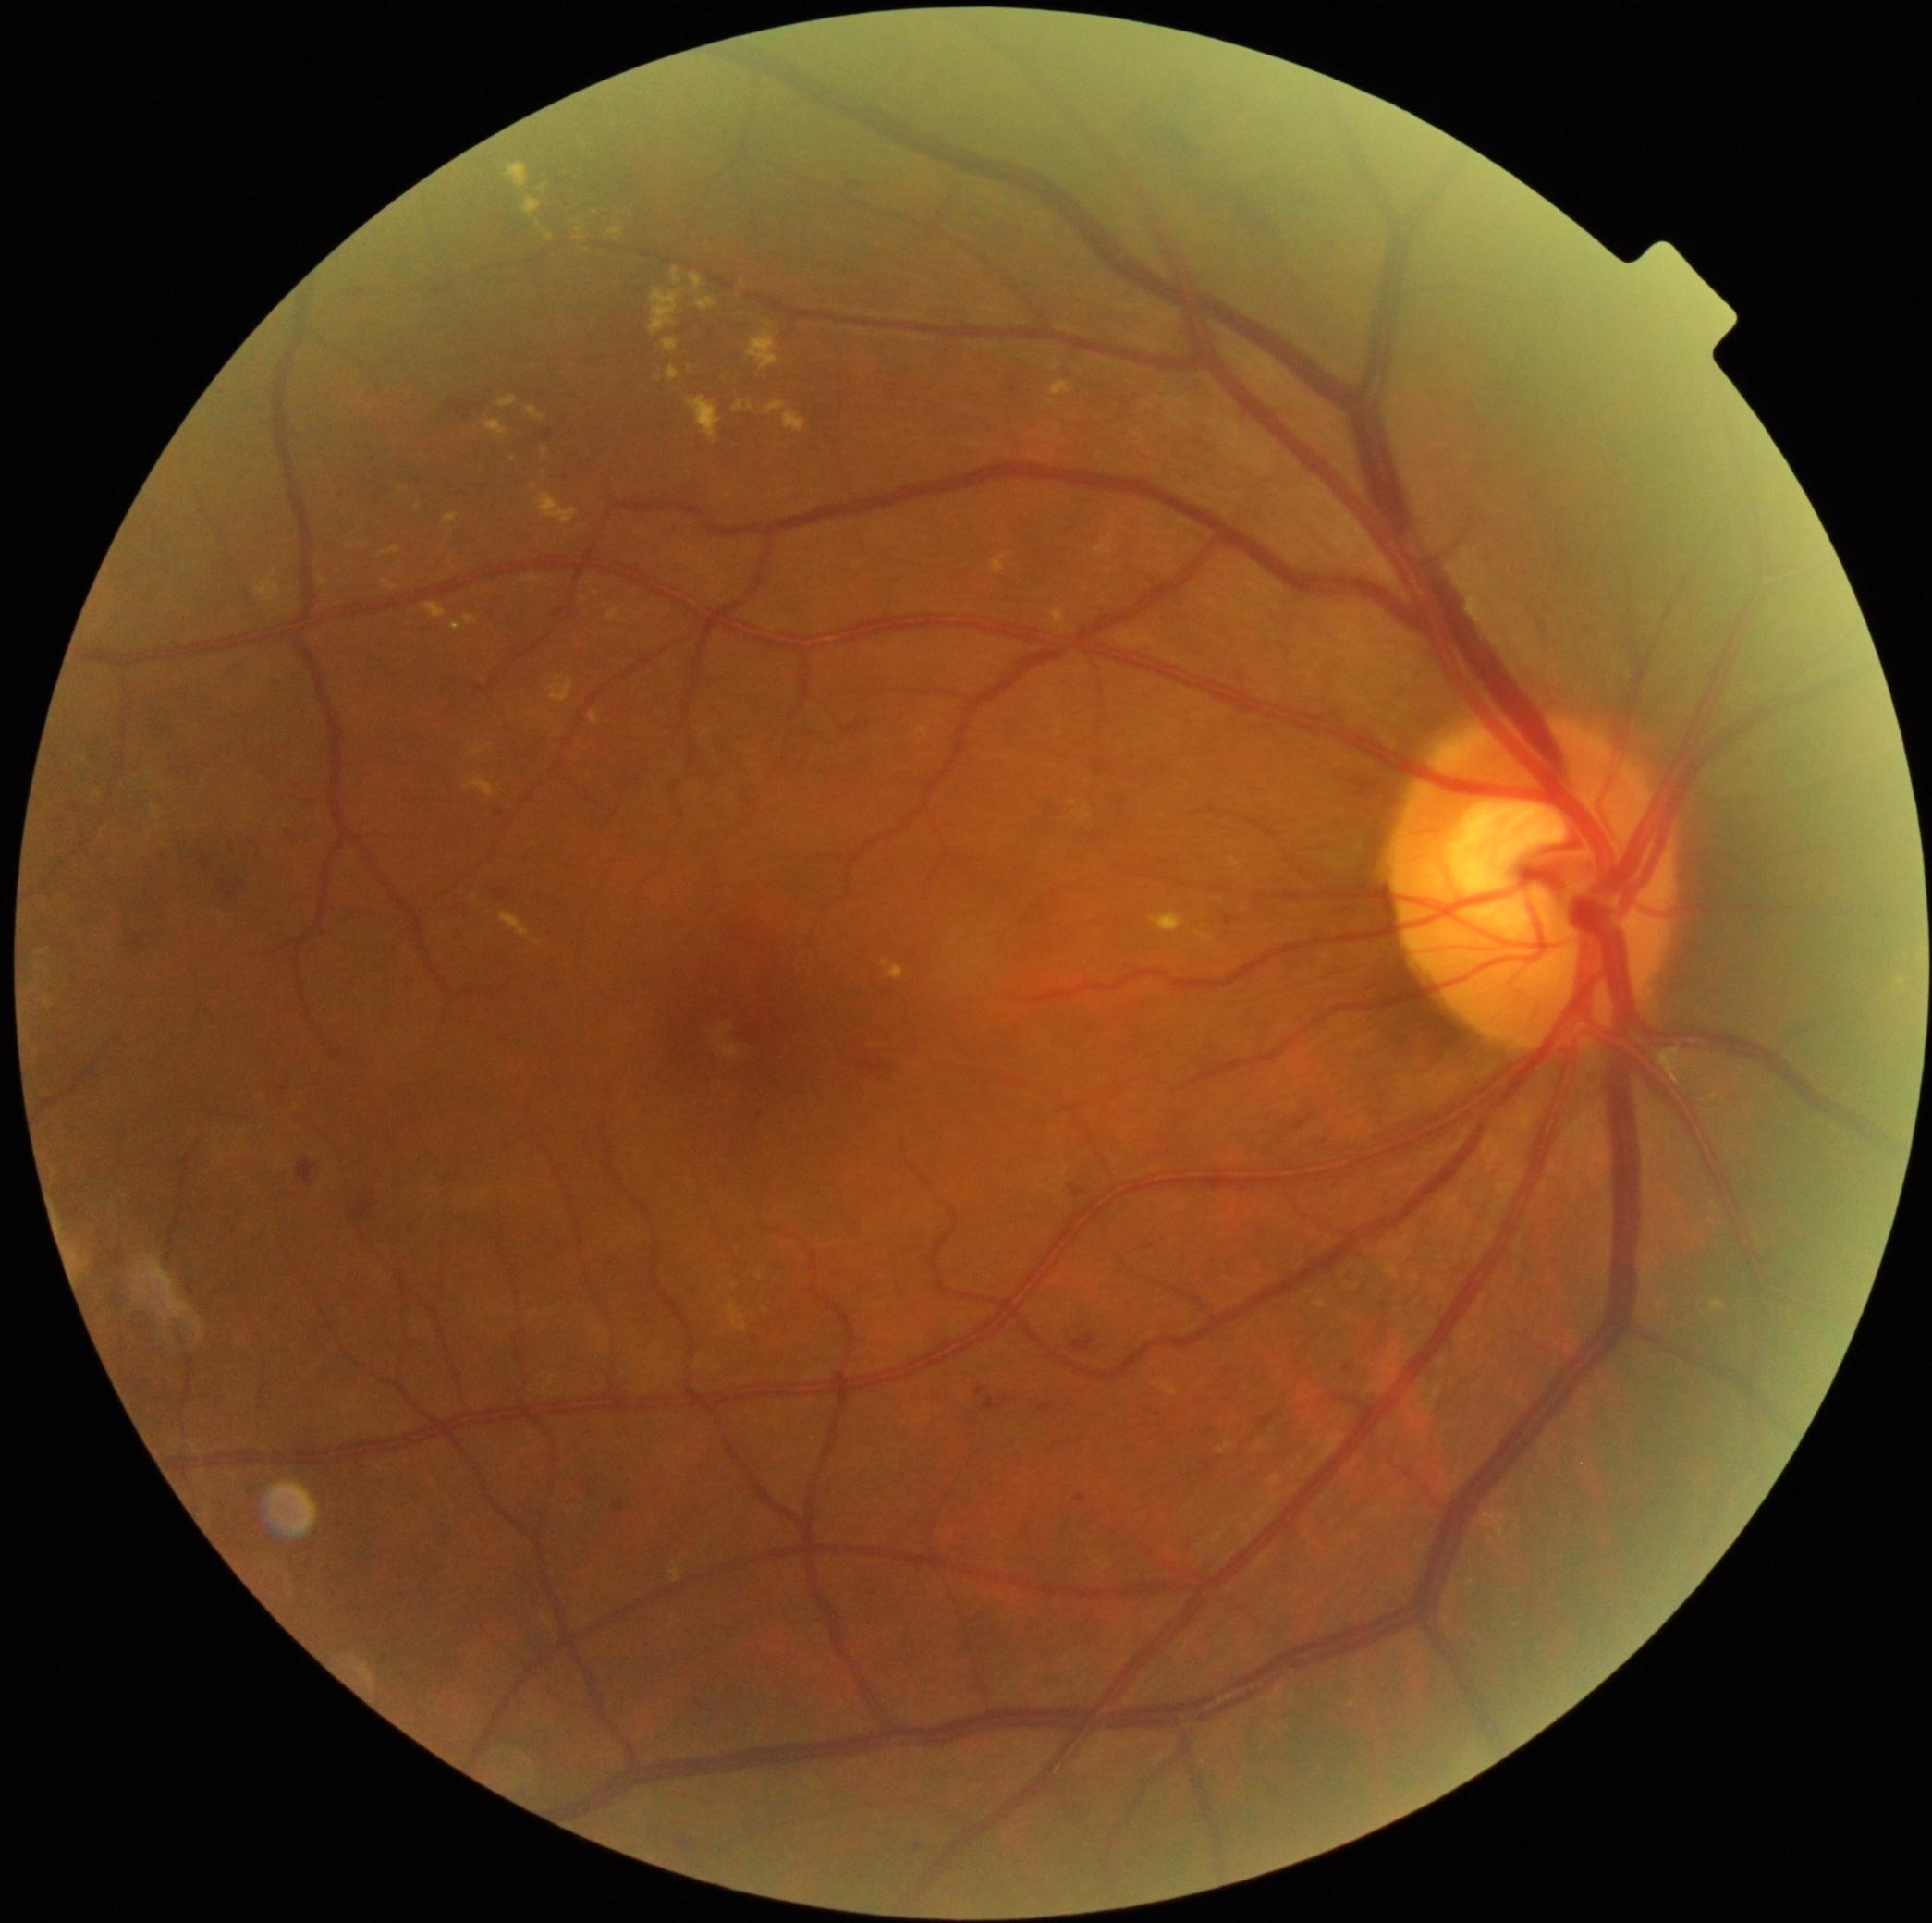 Diabetic retinopathy is grade 2 (moderate NPDR).
Hemorrhages identified at [left=1327, top=237, right=1337, bottom=248] | [left=352, top=1189, right=381, bottom=1219] | [left=220, top=875, right=250, bottom=903] | [left=1278, top=173, right=1324, bottom=205] | [left=175, top=750, right=199, bottom=776] | [left=434, top=392, right=495, bottom=420] | [left=140, top=703, right=165, bottom=742] | [left=1198, top=127, right=1210, bottom=134] | [left=291, top=1163, right=319, bottom=1183] | [left=1296, top=1114, right=1316, bottom=1132] | [left=55, top=811, right=72, bottom=832] | [left=118, top=933, right=151, bottom=957] | [left=1125, top=81, right=1311, bottom=308] | [left=197, top=856, right=222, bottom=875] | [left=1071, top=1335, right=1097, bottom=1353].
Microaneurysms include [left=1037, top=1404, right=1050, bottom=1412] | [left=1225, top=916, right=1238, bottom=925] | [left=982, top=1397, right=1011, bottom=1412] | [left=1075, top=1496, right=1088, bottom=1504] | [left=545, top=429, right=555, bottom=439] | [left=615, top=1503, right=626, bottom=1513] | [left=1075, top=1191, right=1086, bottom=1199] | [left=976, top=1388, right=987, bottom=1397].
Small microaneurysms near 761:1116 | 1347:1370.
Hard exudates include [left=1094, top=533, right=1116, bottom=558] | [left=1150, top=913, right=1185, bottom=935] | [left=690, top=274, right=704, bottom=291] | [left=591, top=712, right=600, bottom=725] | [left=1316, top=1302, right=1327, bottom=1309] | [left=544, top=448, right=549, bottom=458] | [left=650, top=289, right=684, bottom=336] | [left=1217, top=1444, right=1234, bottom=1455] | [left=673, top=268, right=682, bottom=286] | [left=764, top=401, right=787, bottom=414] | [left=423, top=604, right=446, bottom=620] | [left=151, top=805, right=164, bottom=823].
Small hard exudates near 157:829 | 401:489 | 365:546 | 475:899 | 752:407 | 583:600.
No soft exudates identified.